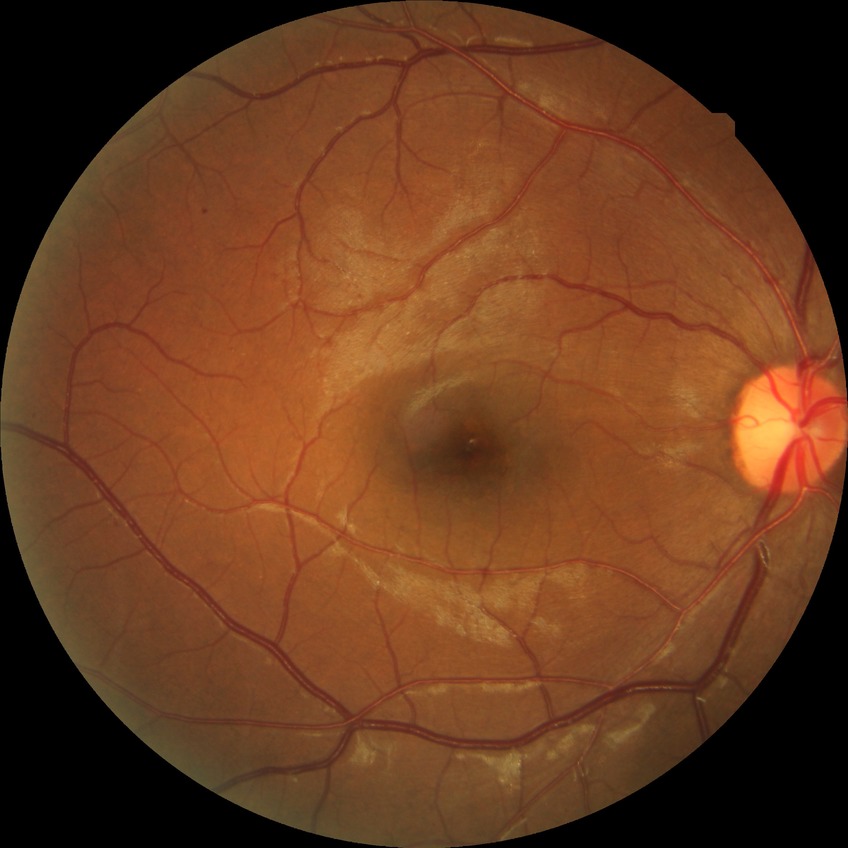 • retinopathy grade: simple diabetic retinopathy